Image size 1380x1382:
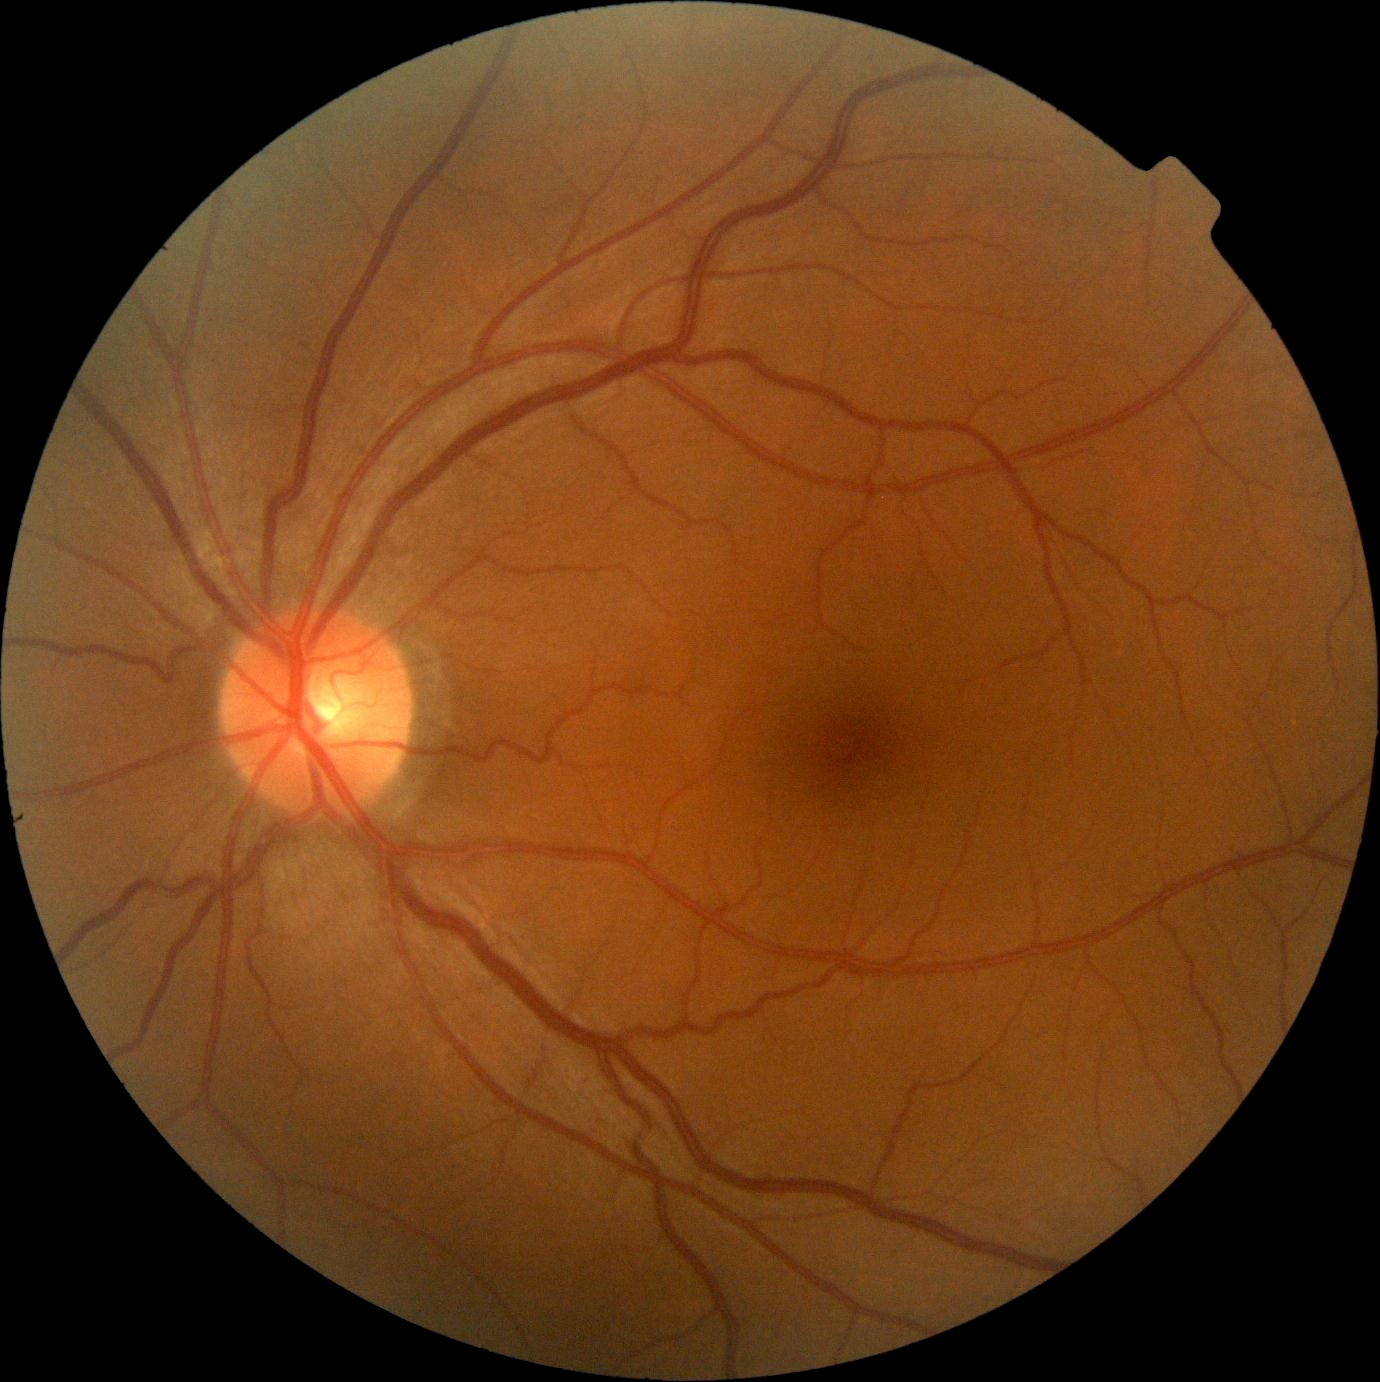

diabetic retinopathy@grade 0, DR impression@no DR findings.